Without pupil dilation: 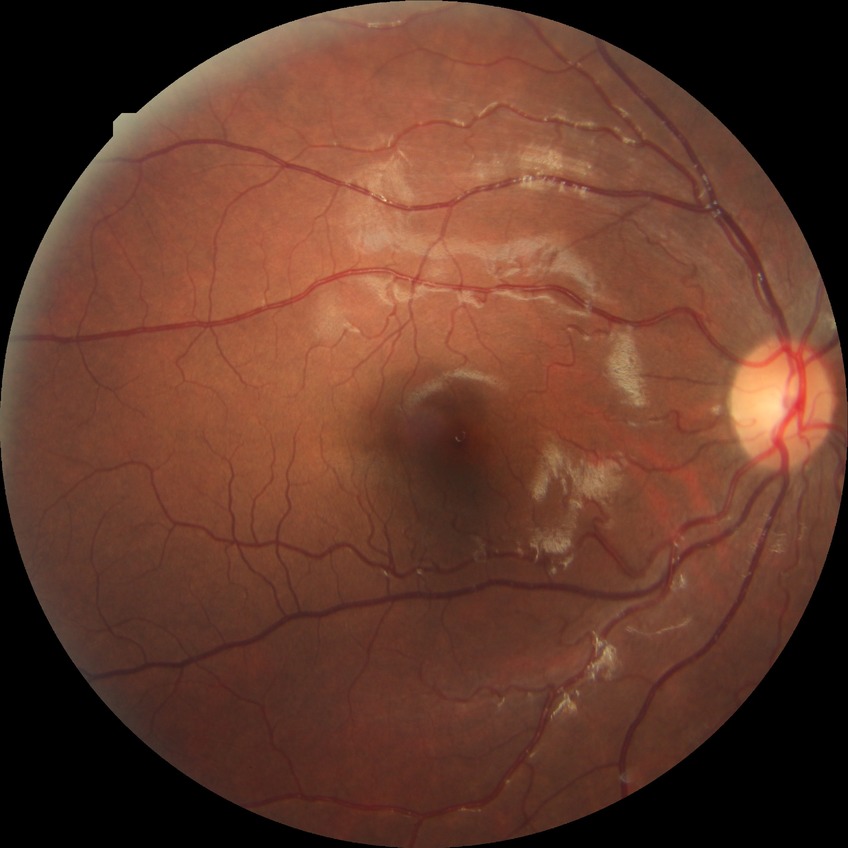 Diabetic retinopathy severity: no diabetic retinopathy.